Nonmydriatic fundus photograph, 848x848:
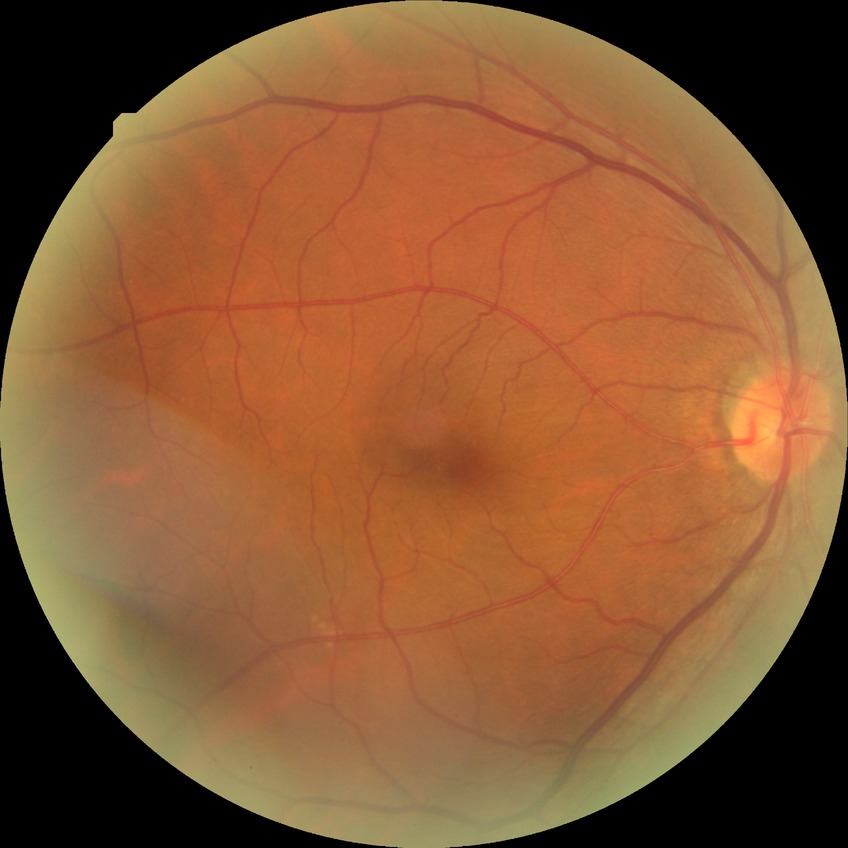 Davis stage is NDR.